Retinal fundus photograph · 512 x 512 pixels
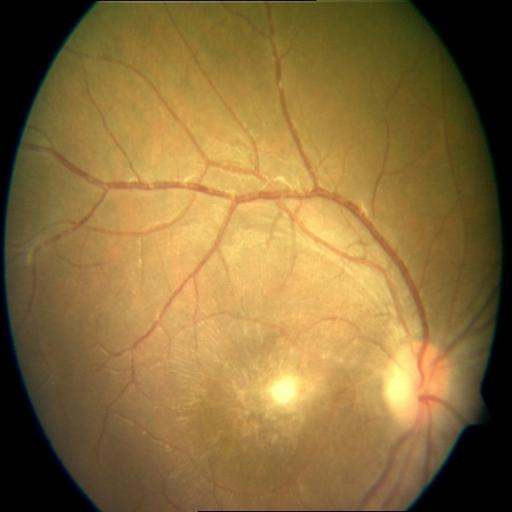 There is evidence of chorioretinitis.